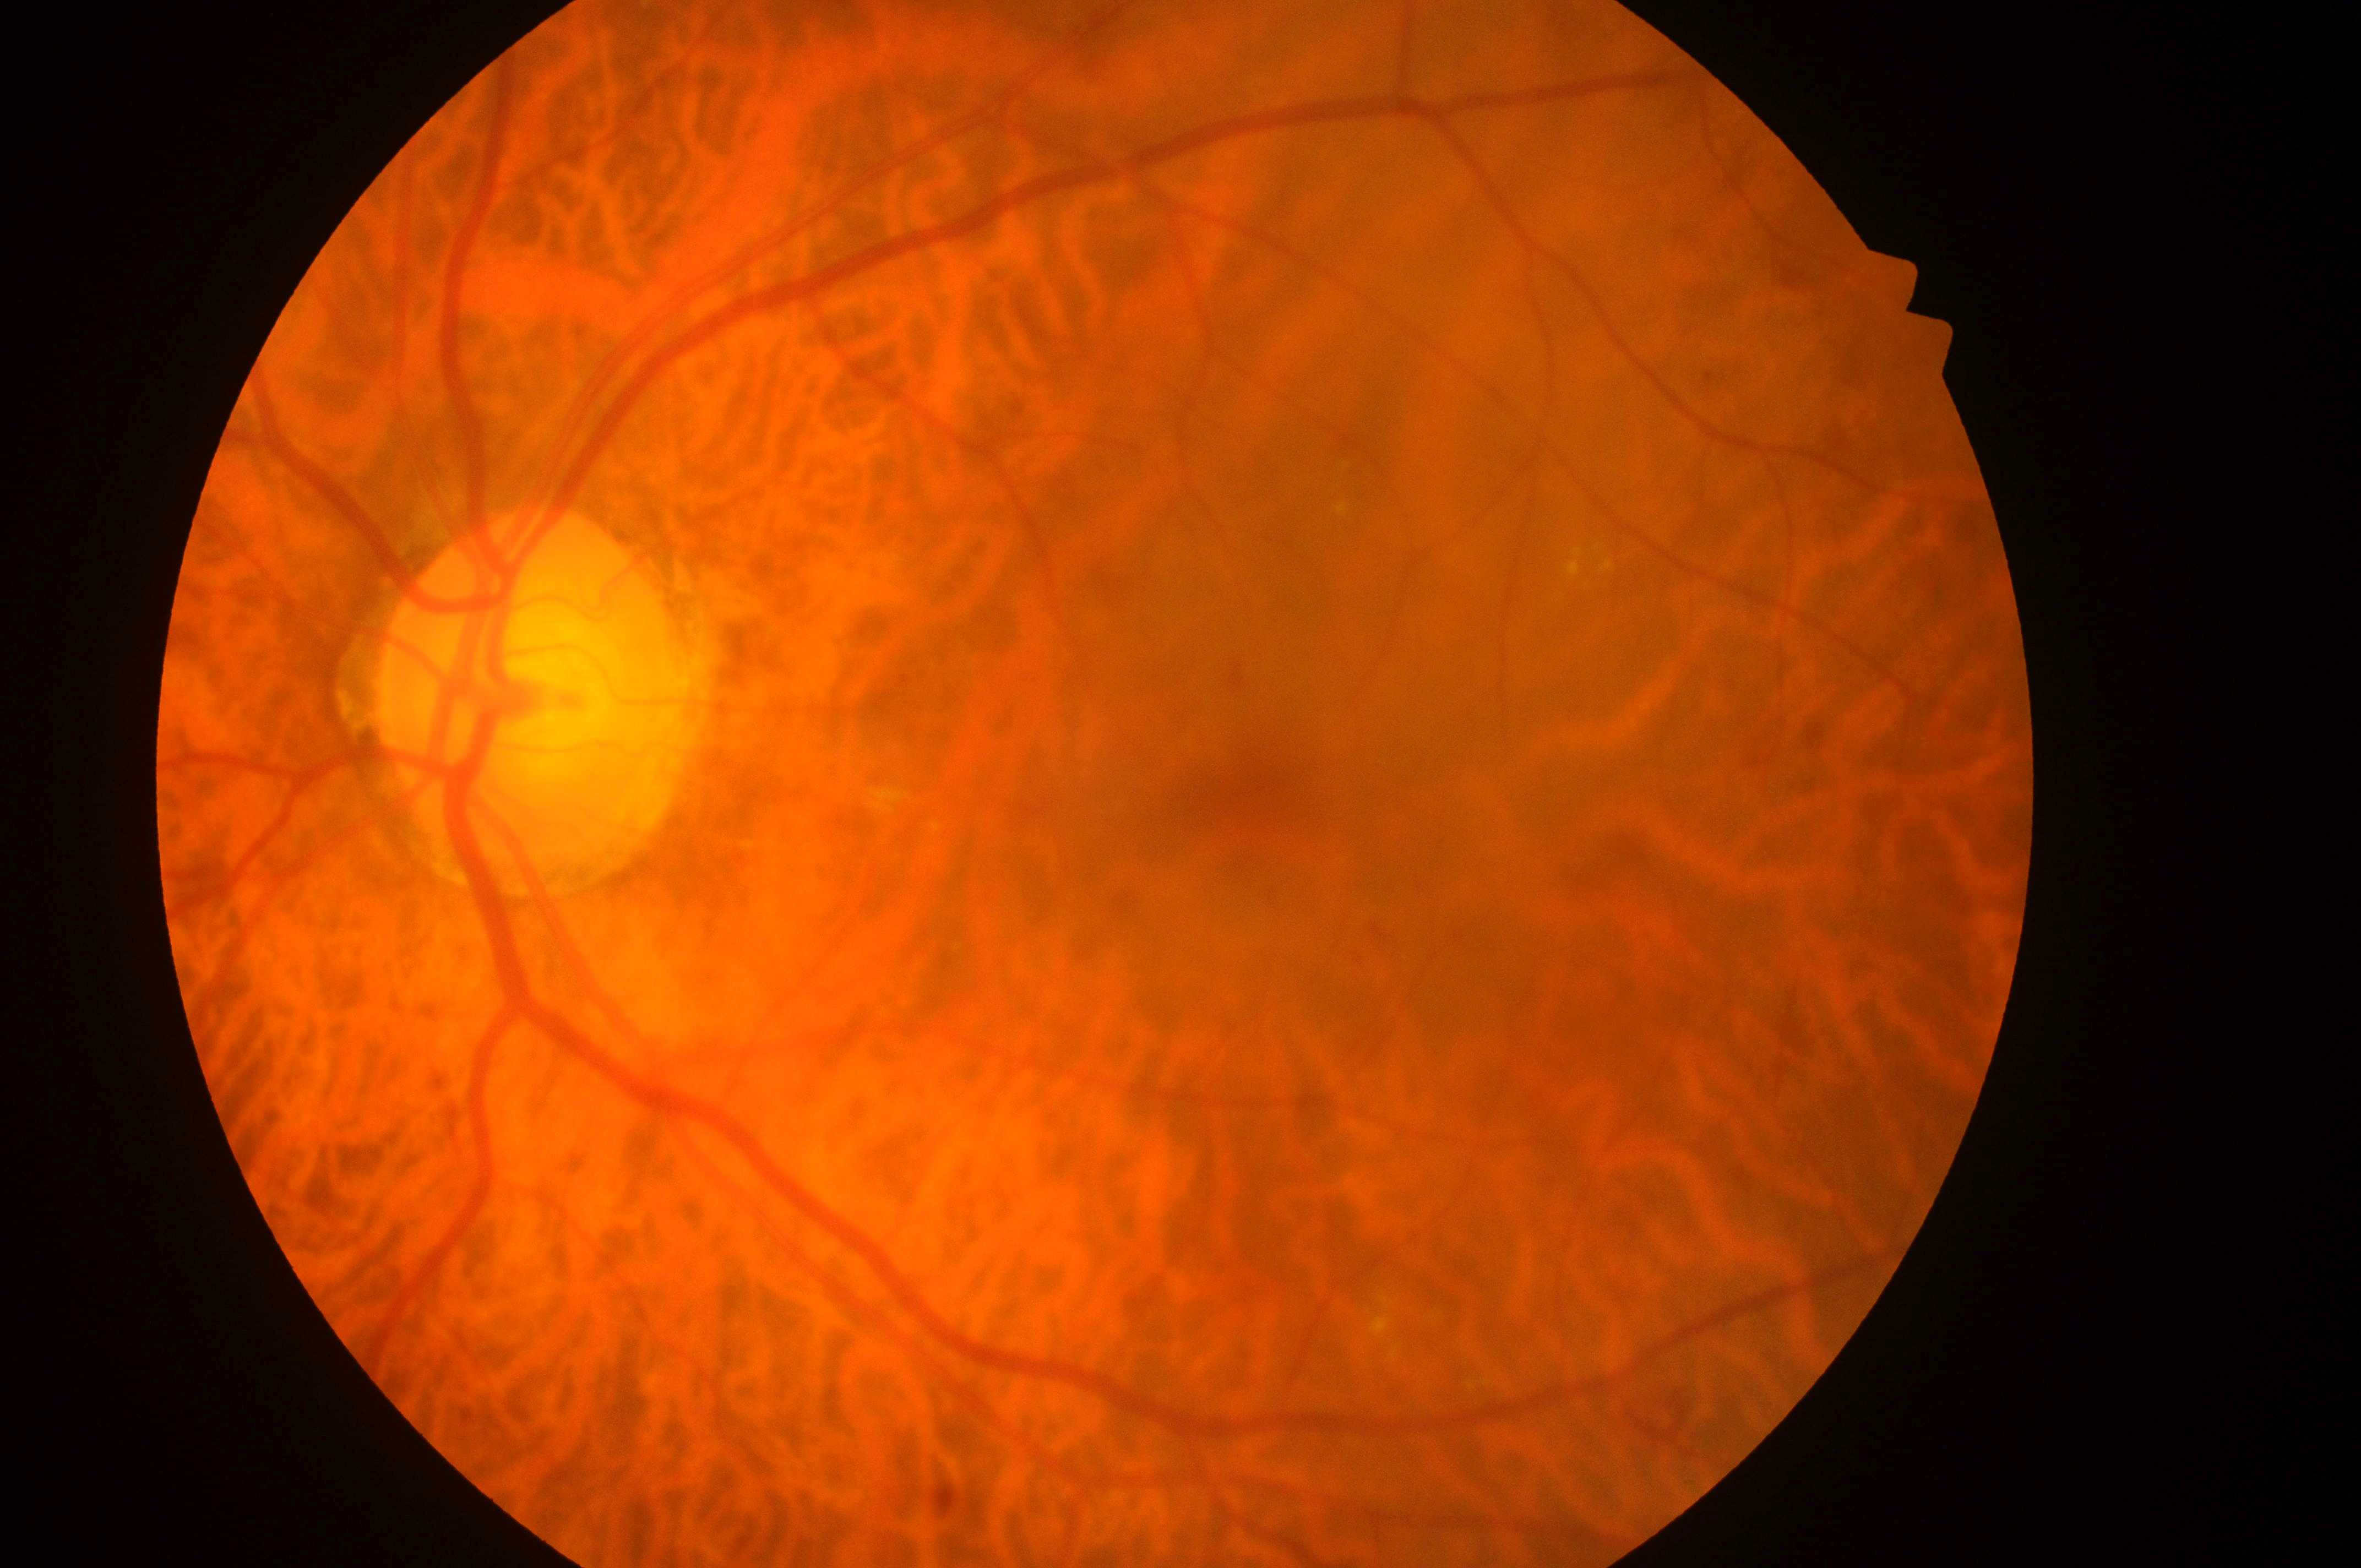 Diabetic retinopathy grade is moderate non-proliferative diabetic retinopathy (2). This is the OS. The fovea center is at [1266, 796]. Optic disc center: [519, 709]. Risk of macular edema is grade 2 (high risk).